FOV: 45 degrees; 2352x1568px:
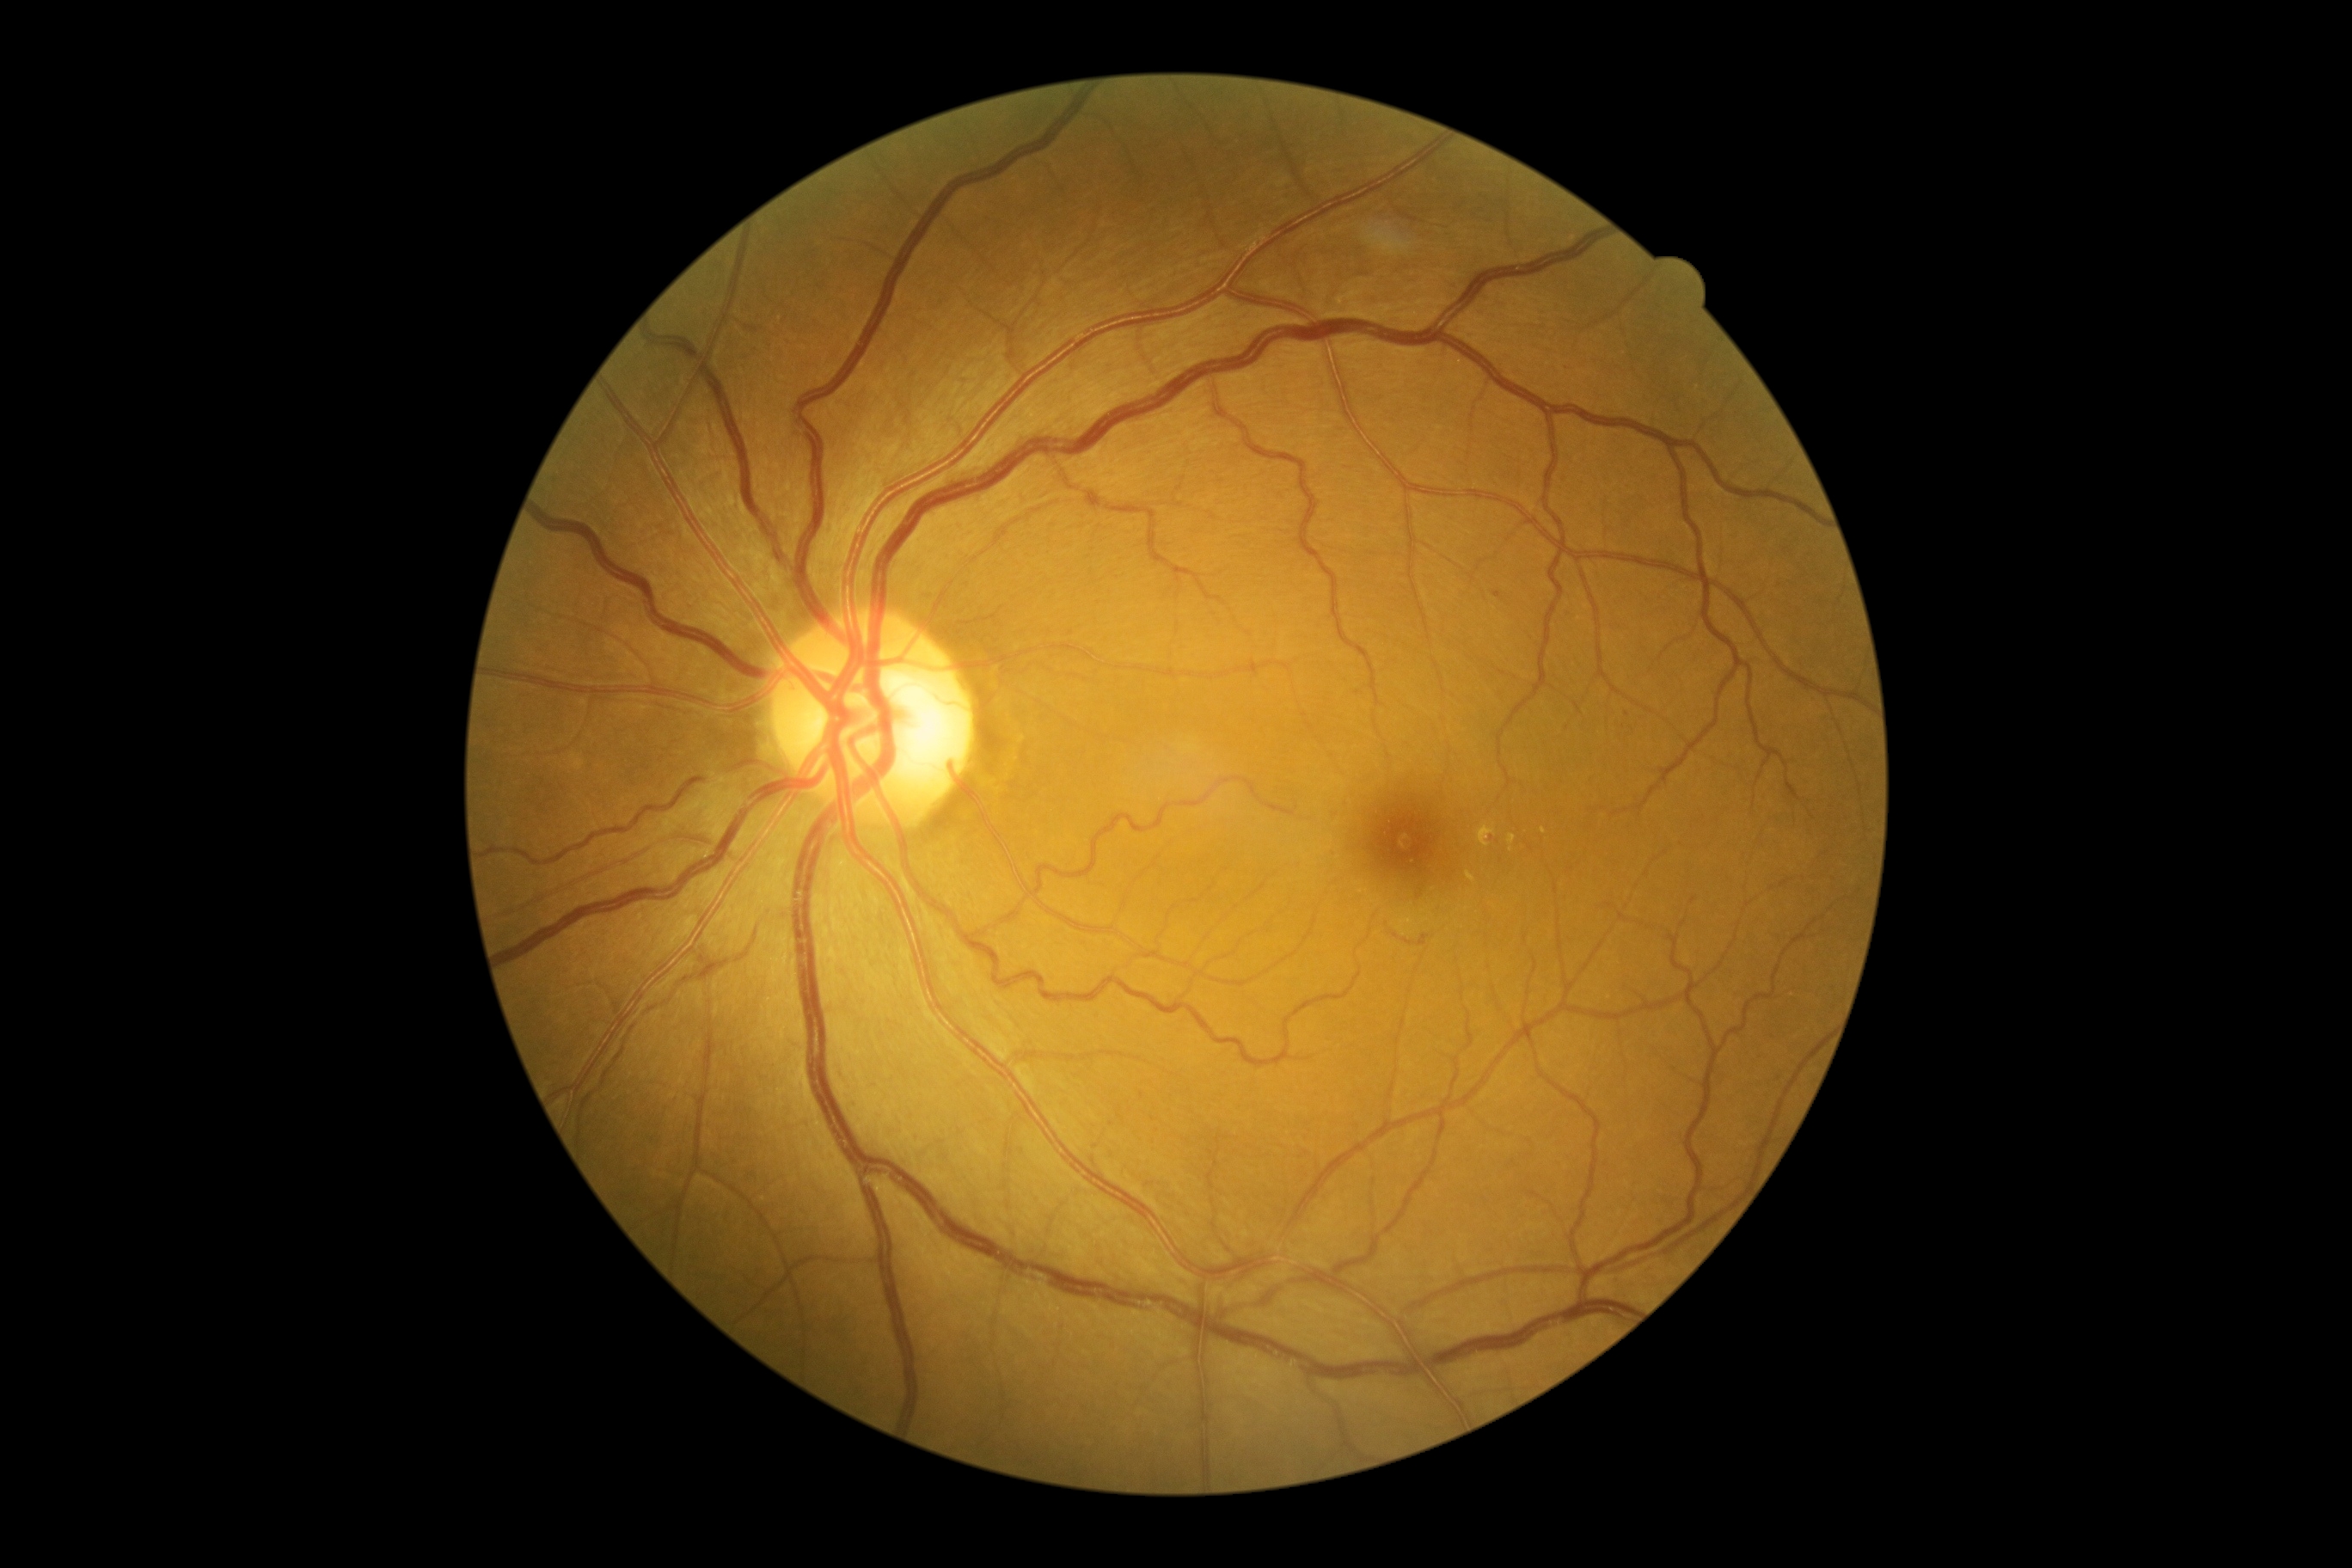 DR severity is grade 2 (moderate NPDR).